Wide-field fundus image from infant ROP screening — 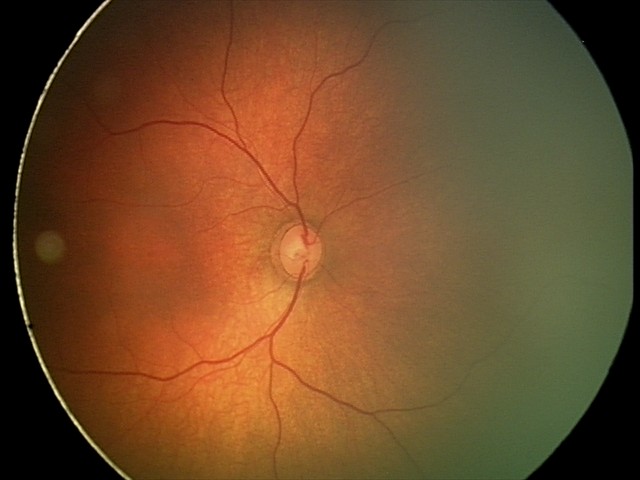

No retinal pathology identified on screening.